45-degree field of view, color fundus image:
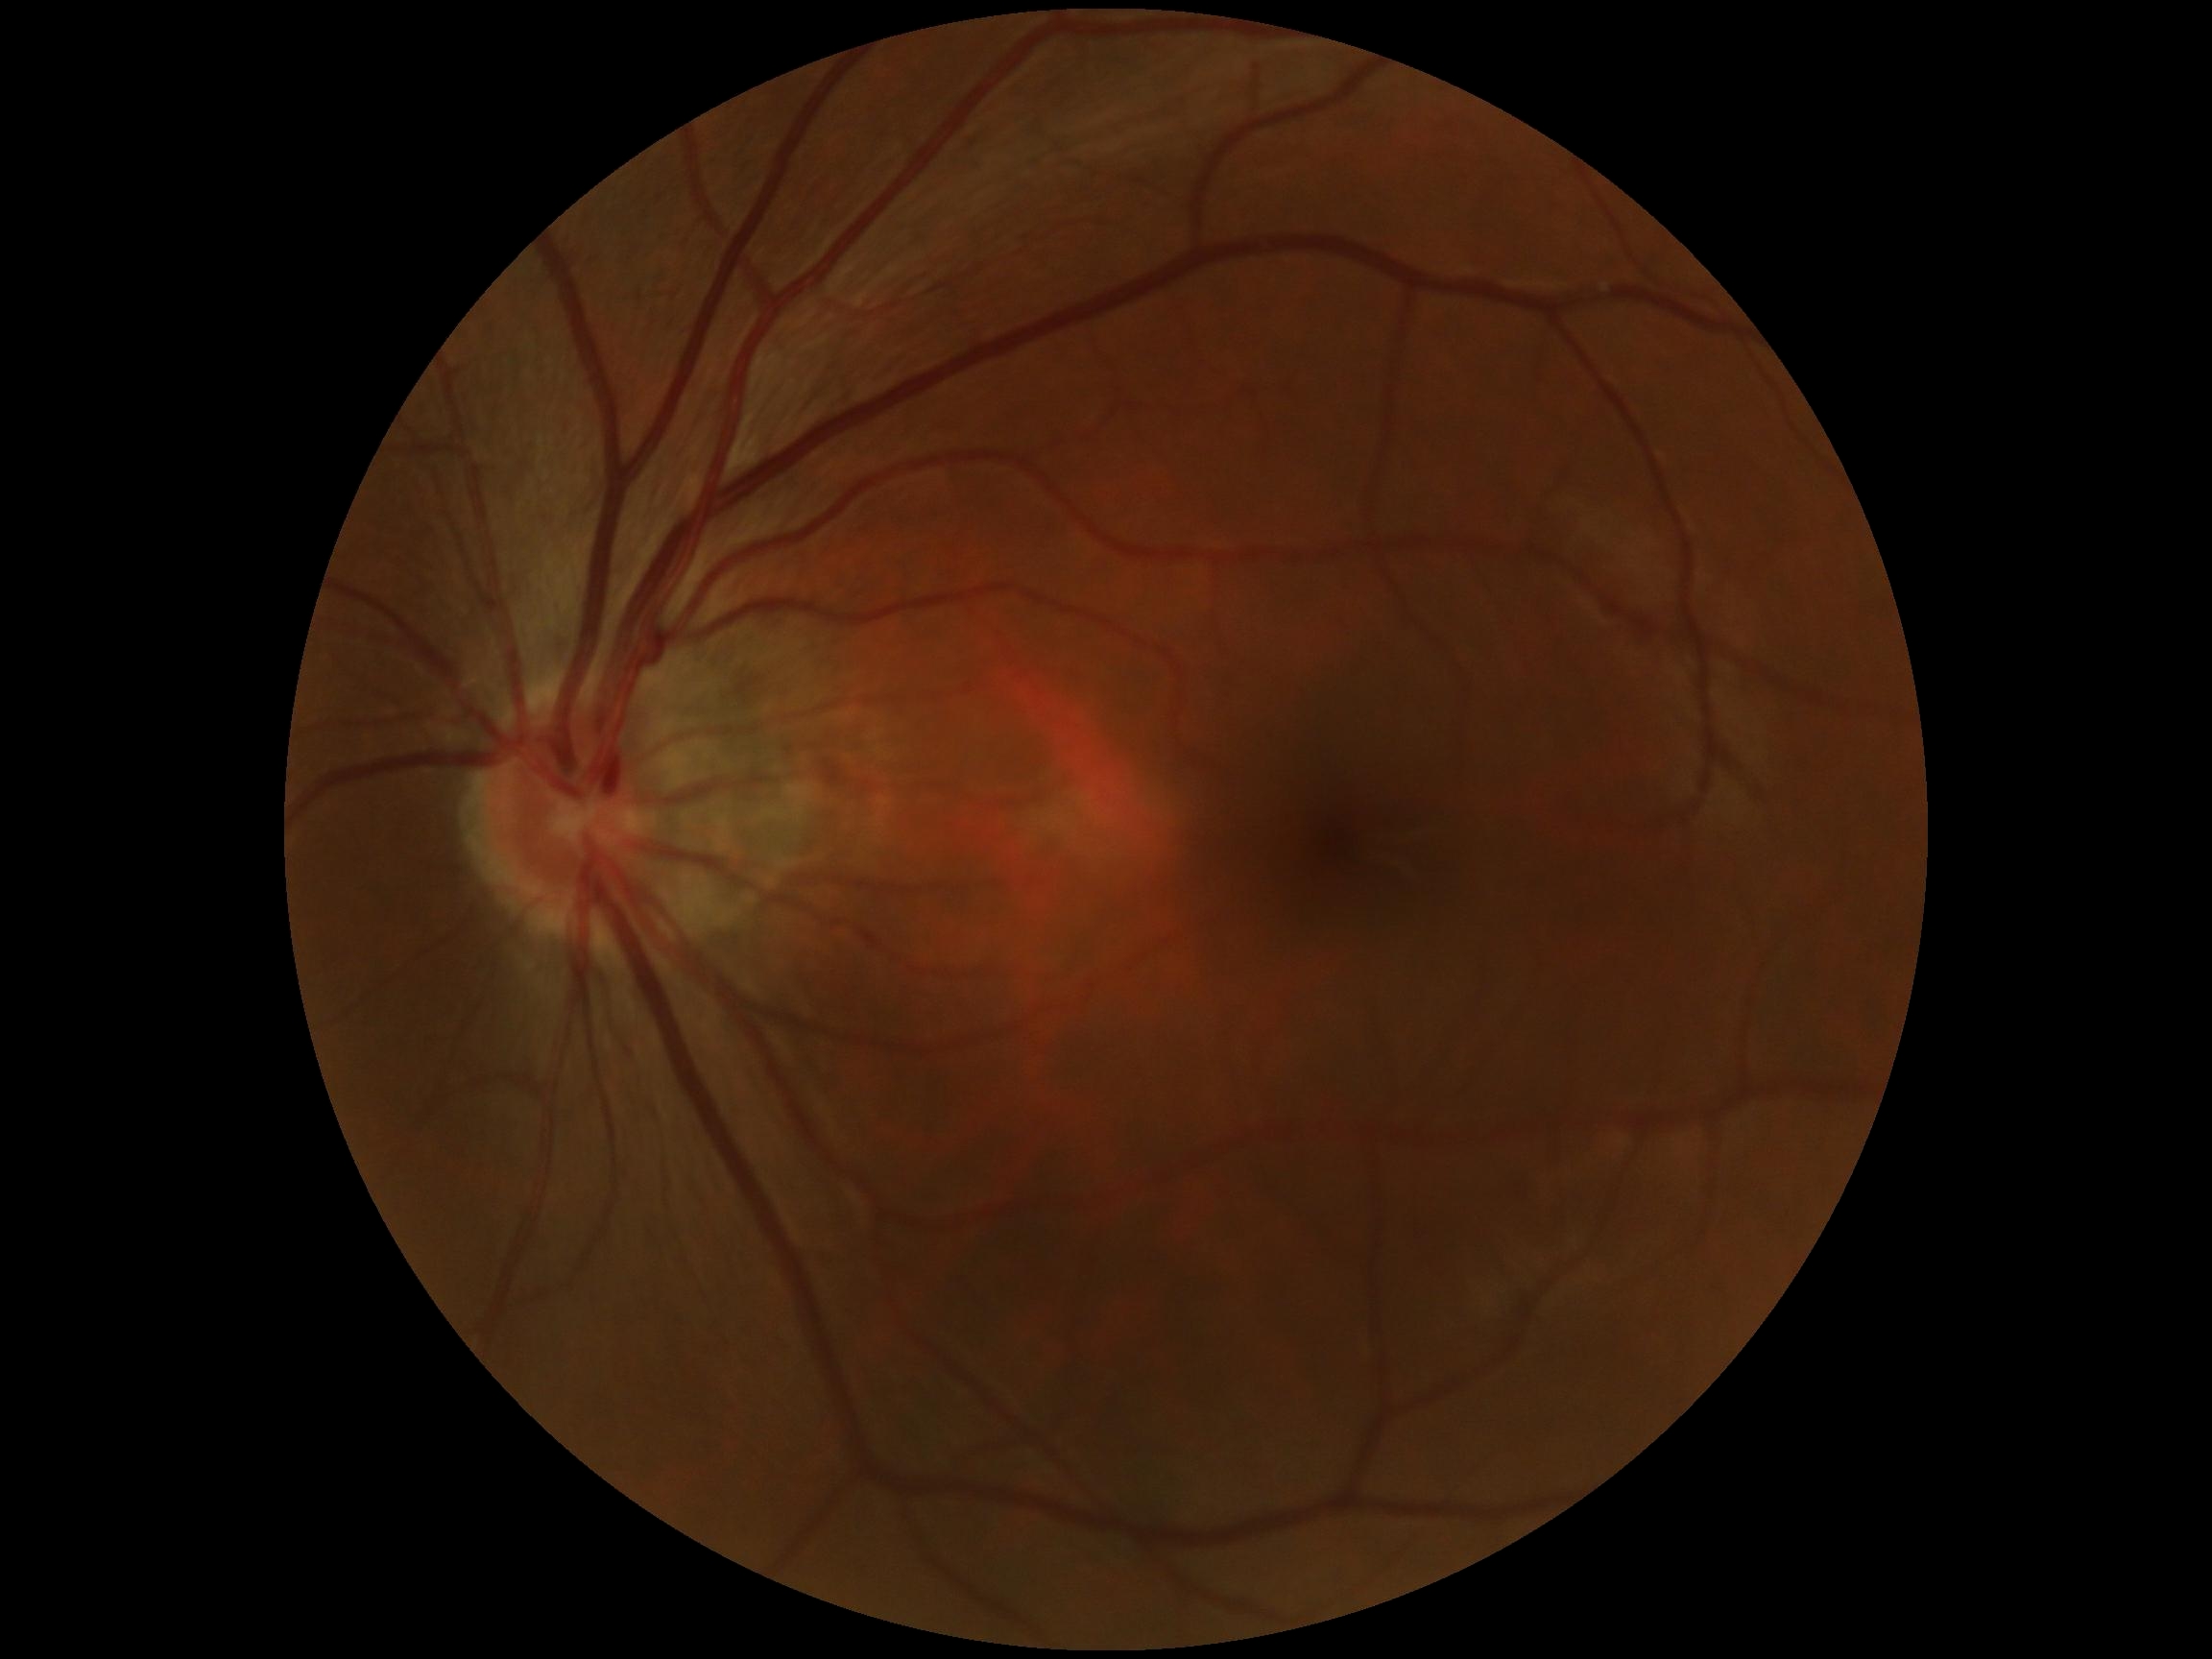

Retinopathy grade is 0 (no apparent retinopathy).